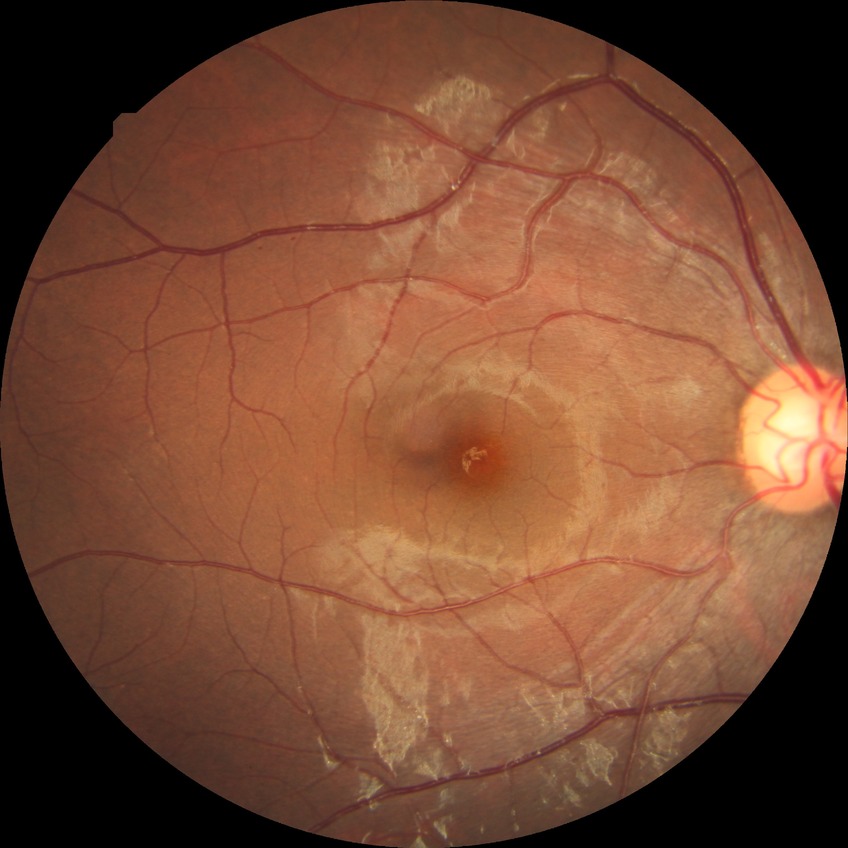 The retinopathy is classified as non-proliferative diabetic retinopathy.
Diabetic retinopathy (DR): simple diabetic retinopathy (SDR).